Acquired on the Clarity RetCam 3 · infant wide-field fundus photograph — 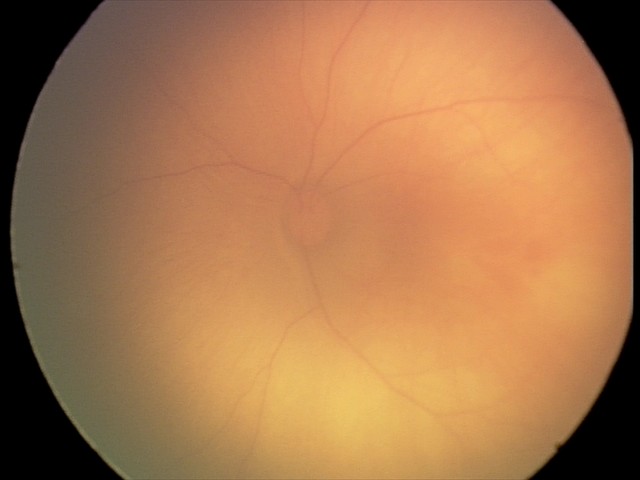
Examination diagnosed as retinal hemorrhages.